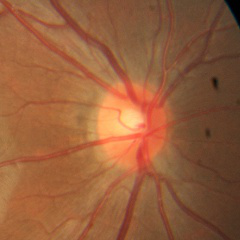 Glaucoma status: no signs of glaucoma.